Infant wide-field fundus photograph: 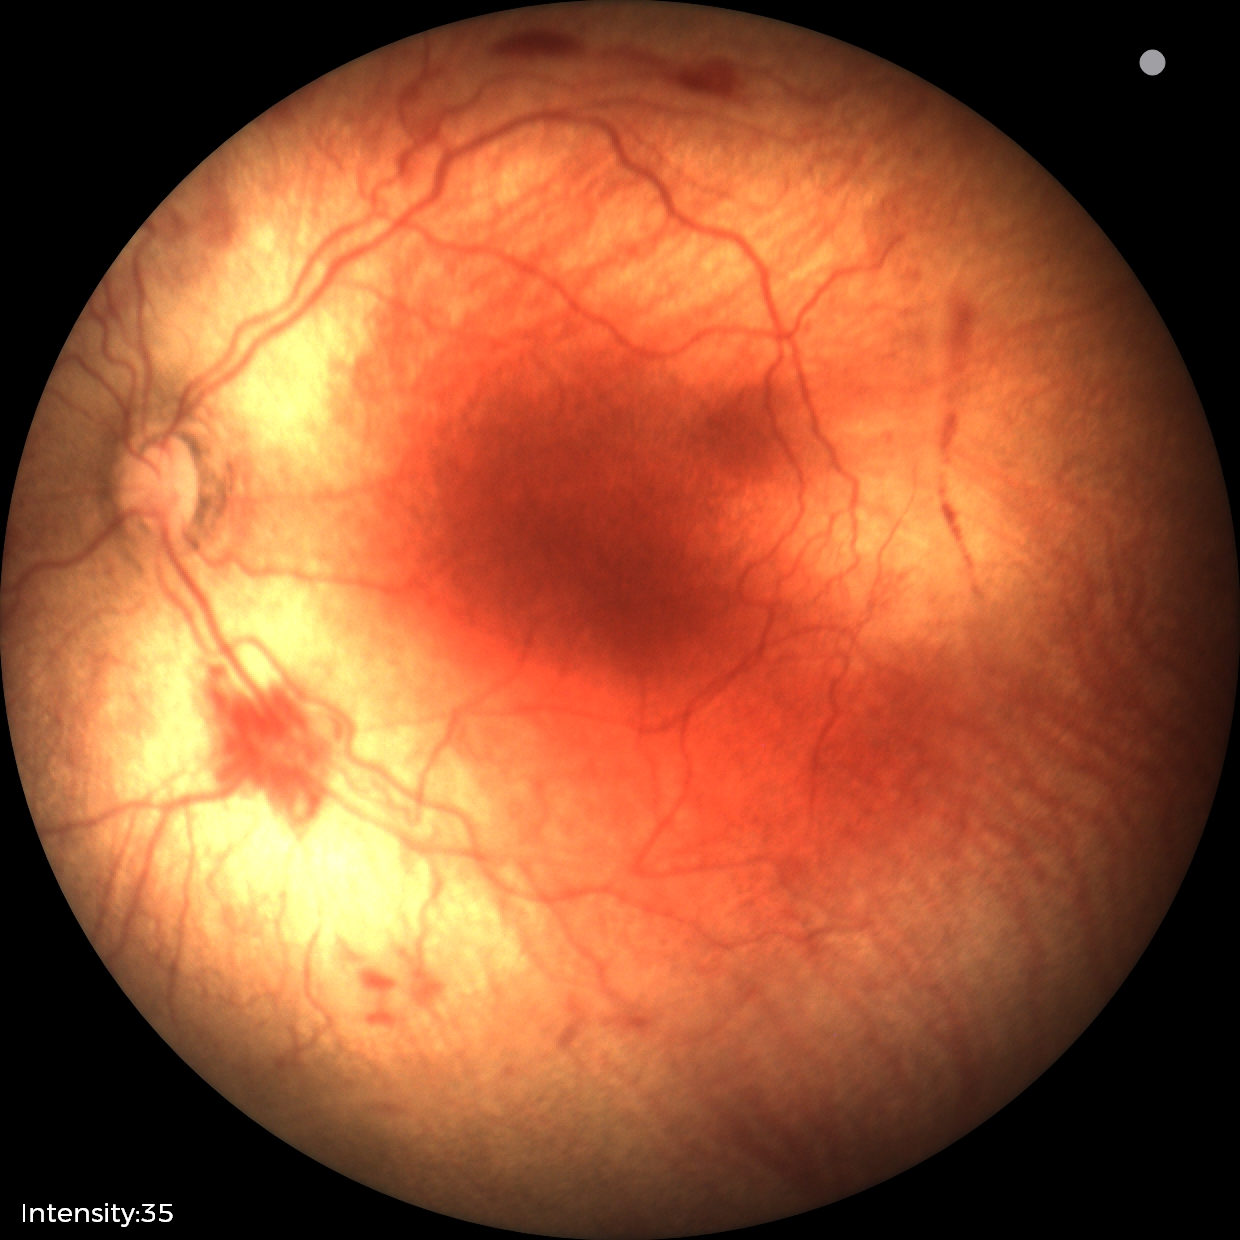
Examination diagnosed as ROP stage 2.
Plus disease present.